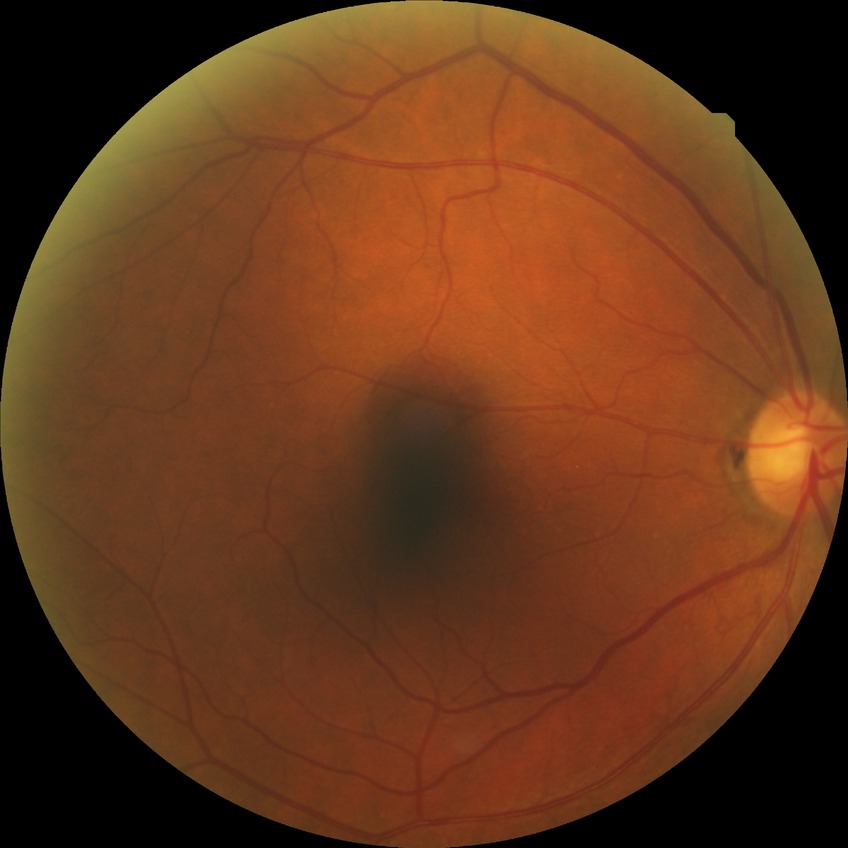 diabetic retinopathy (DR)@NDR (no diabetic retinopathy).